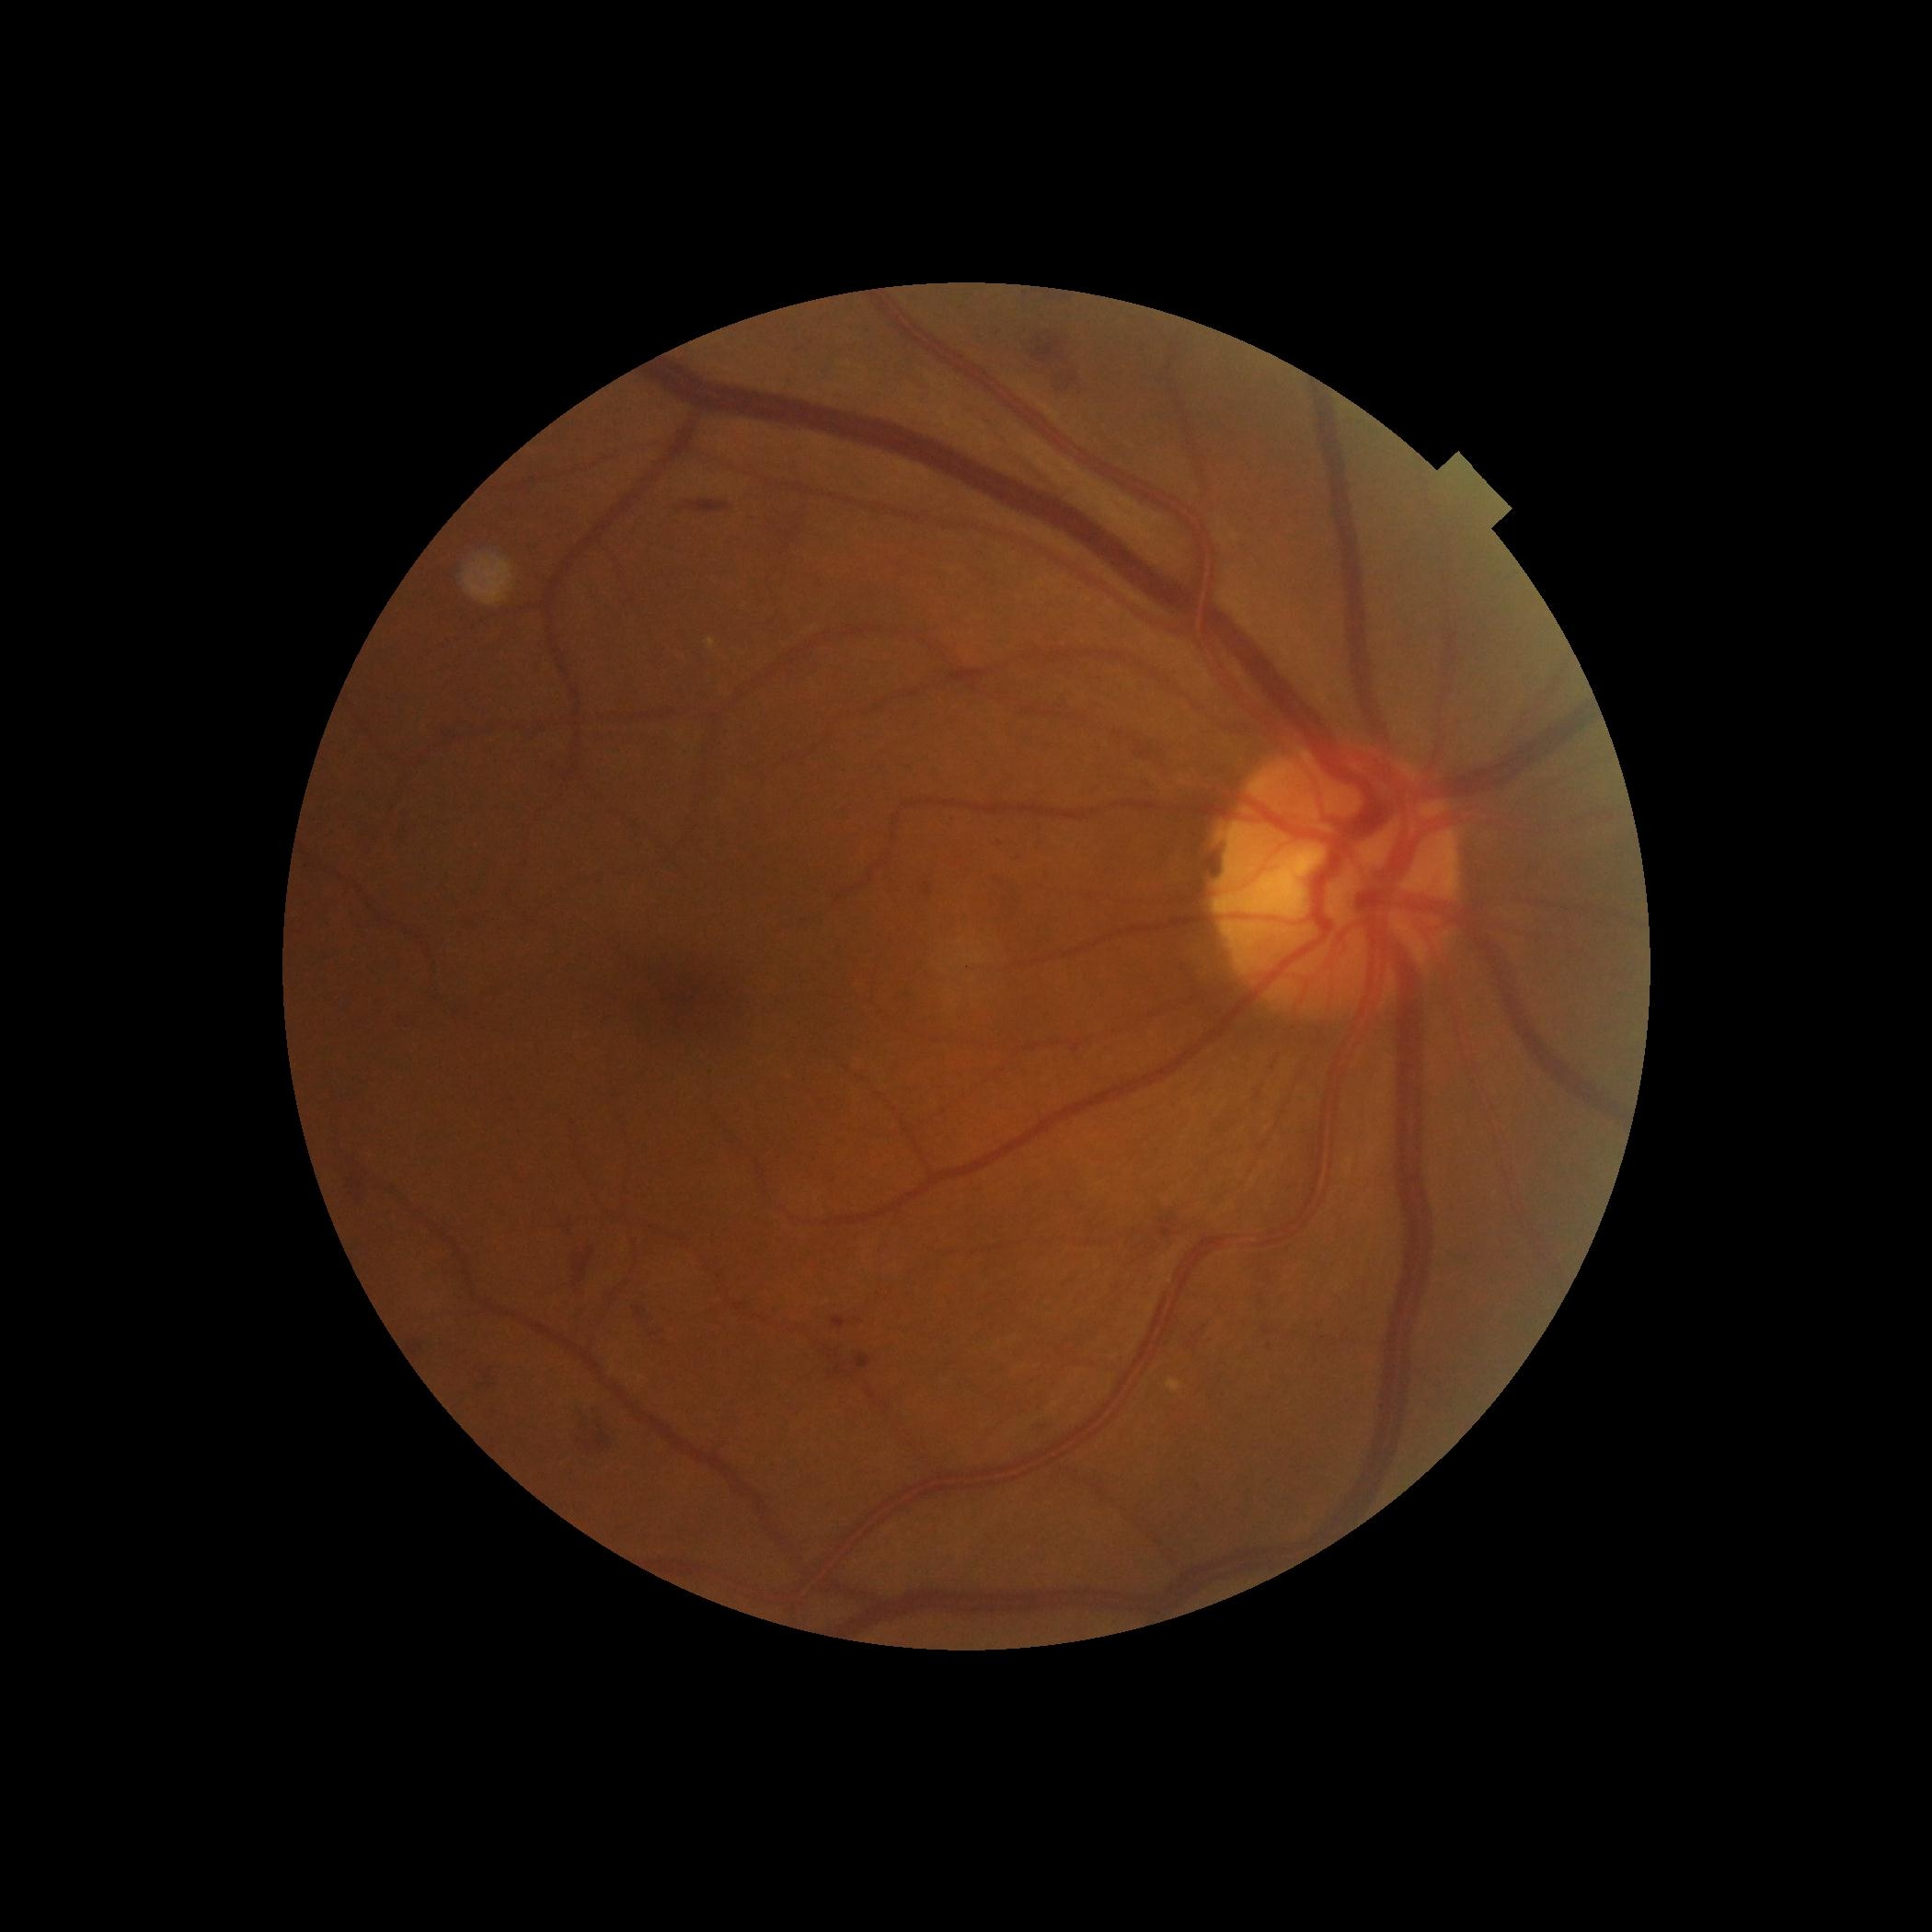
DR class: non-proliferative diabetic retinopathy. DR: moderate non-proliferative diabetic retinopathy (grade 2).